FOV: 45 degrees. 2212 by 1659 pixels. Color fundus image:
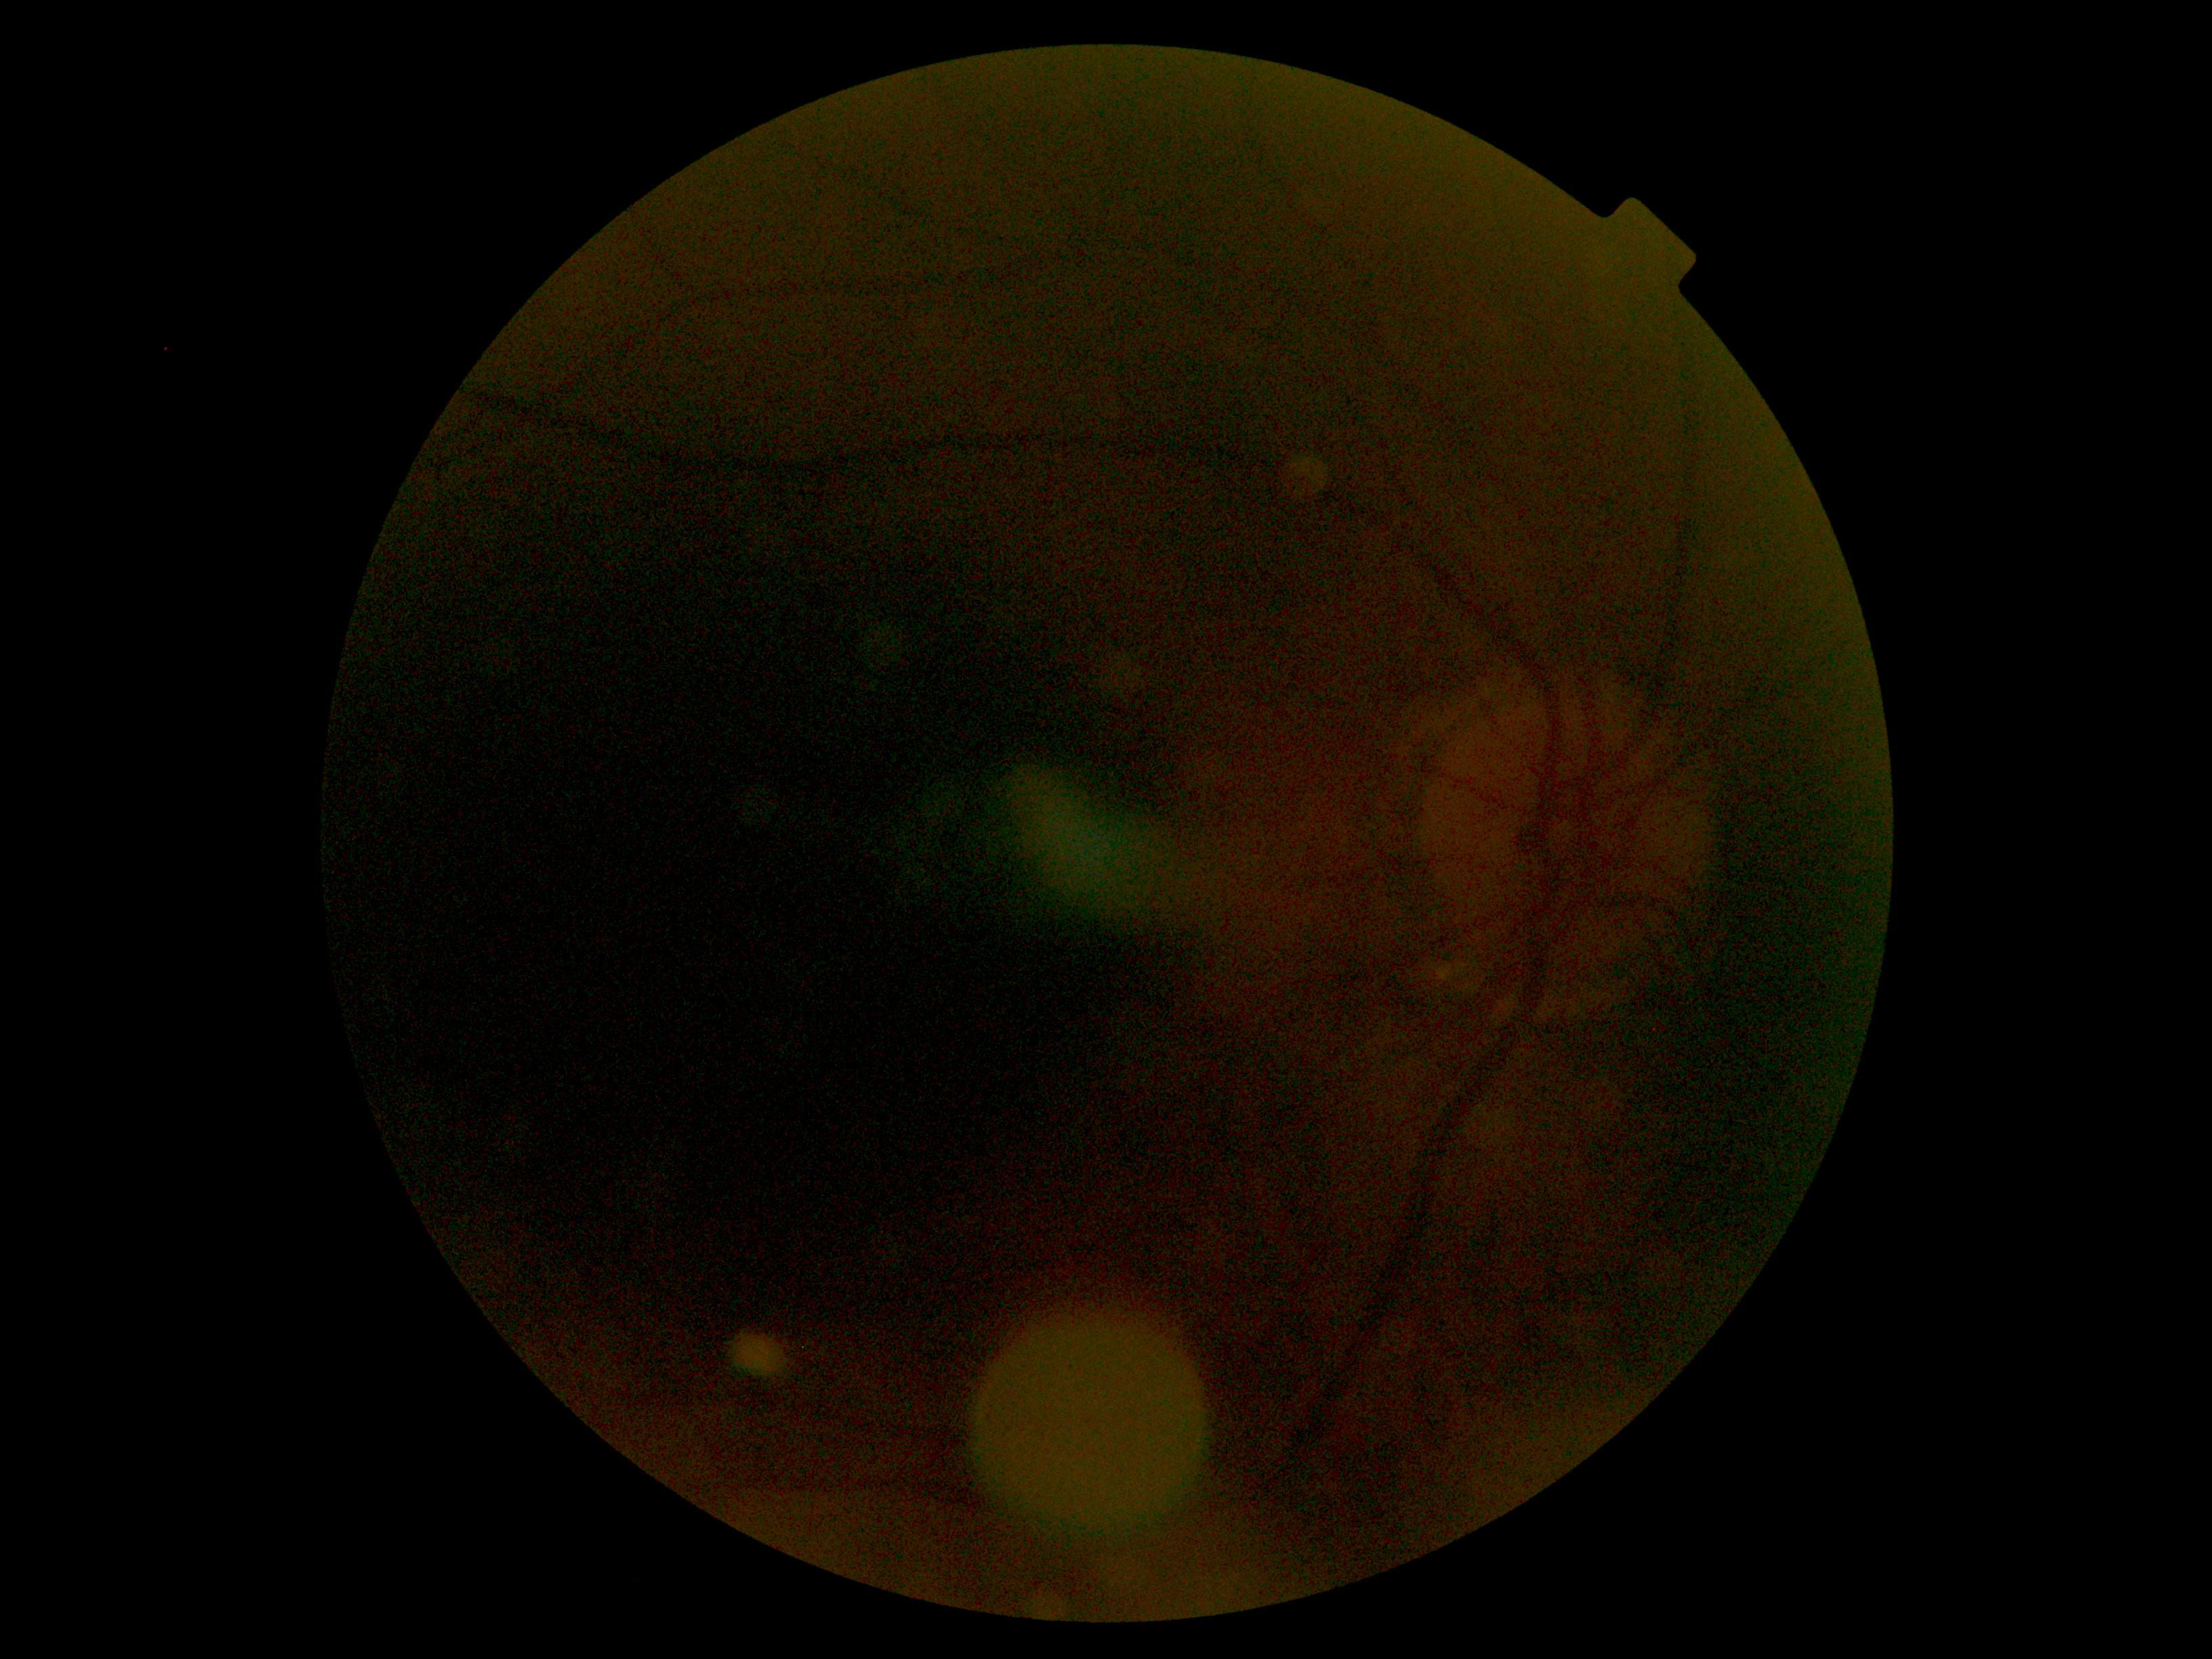 DR: ungradable due to poor image quality.